Ultra-widefield (UWF) fundus image — 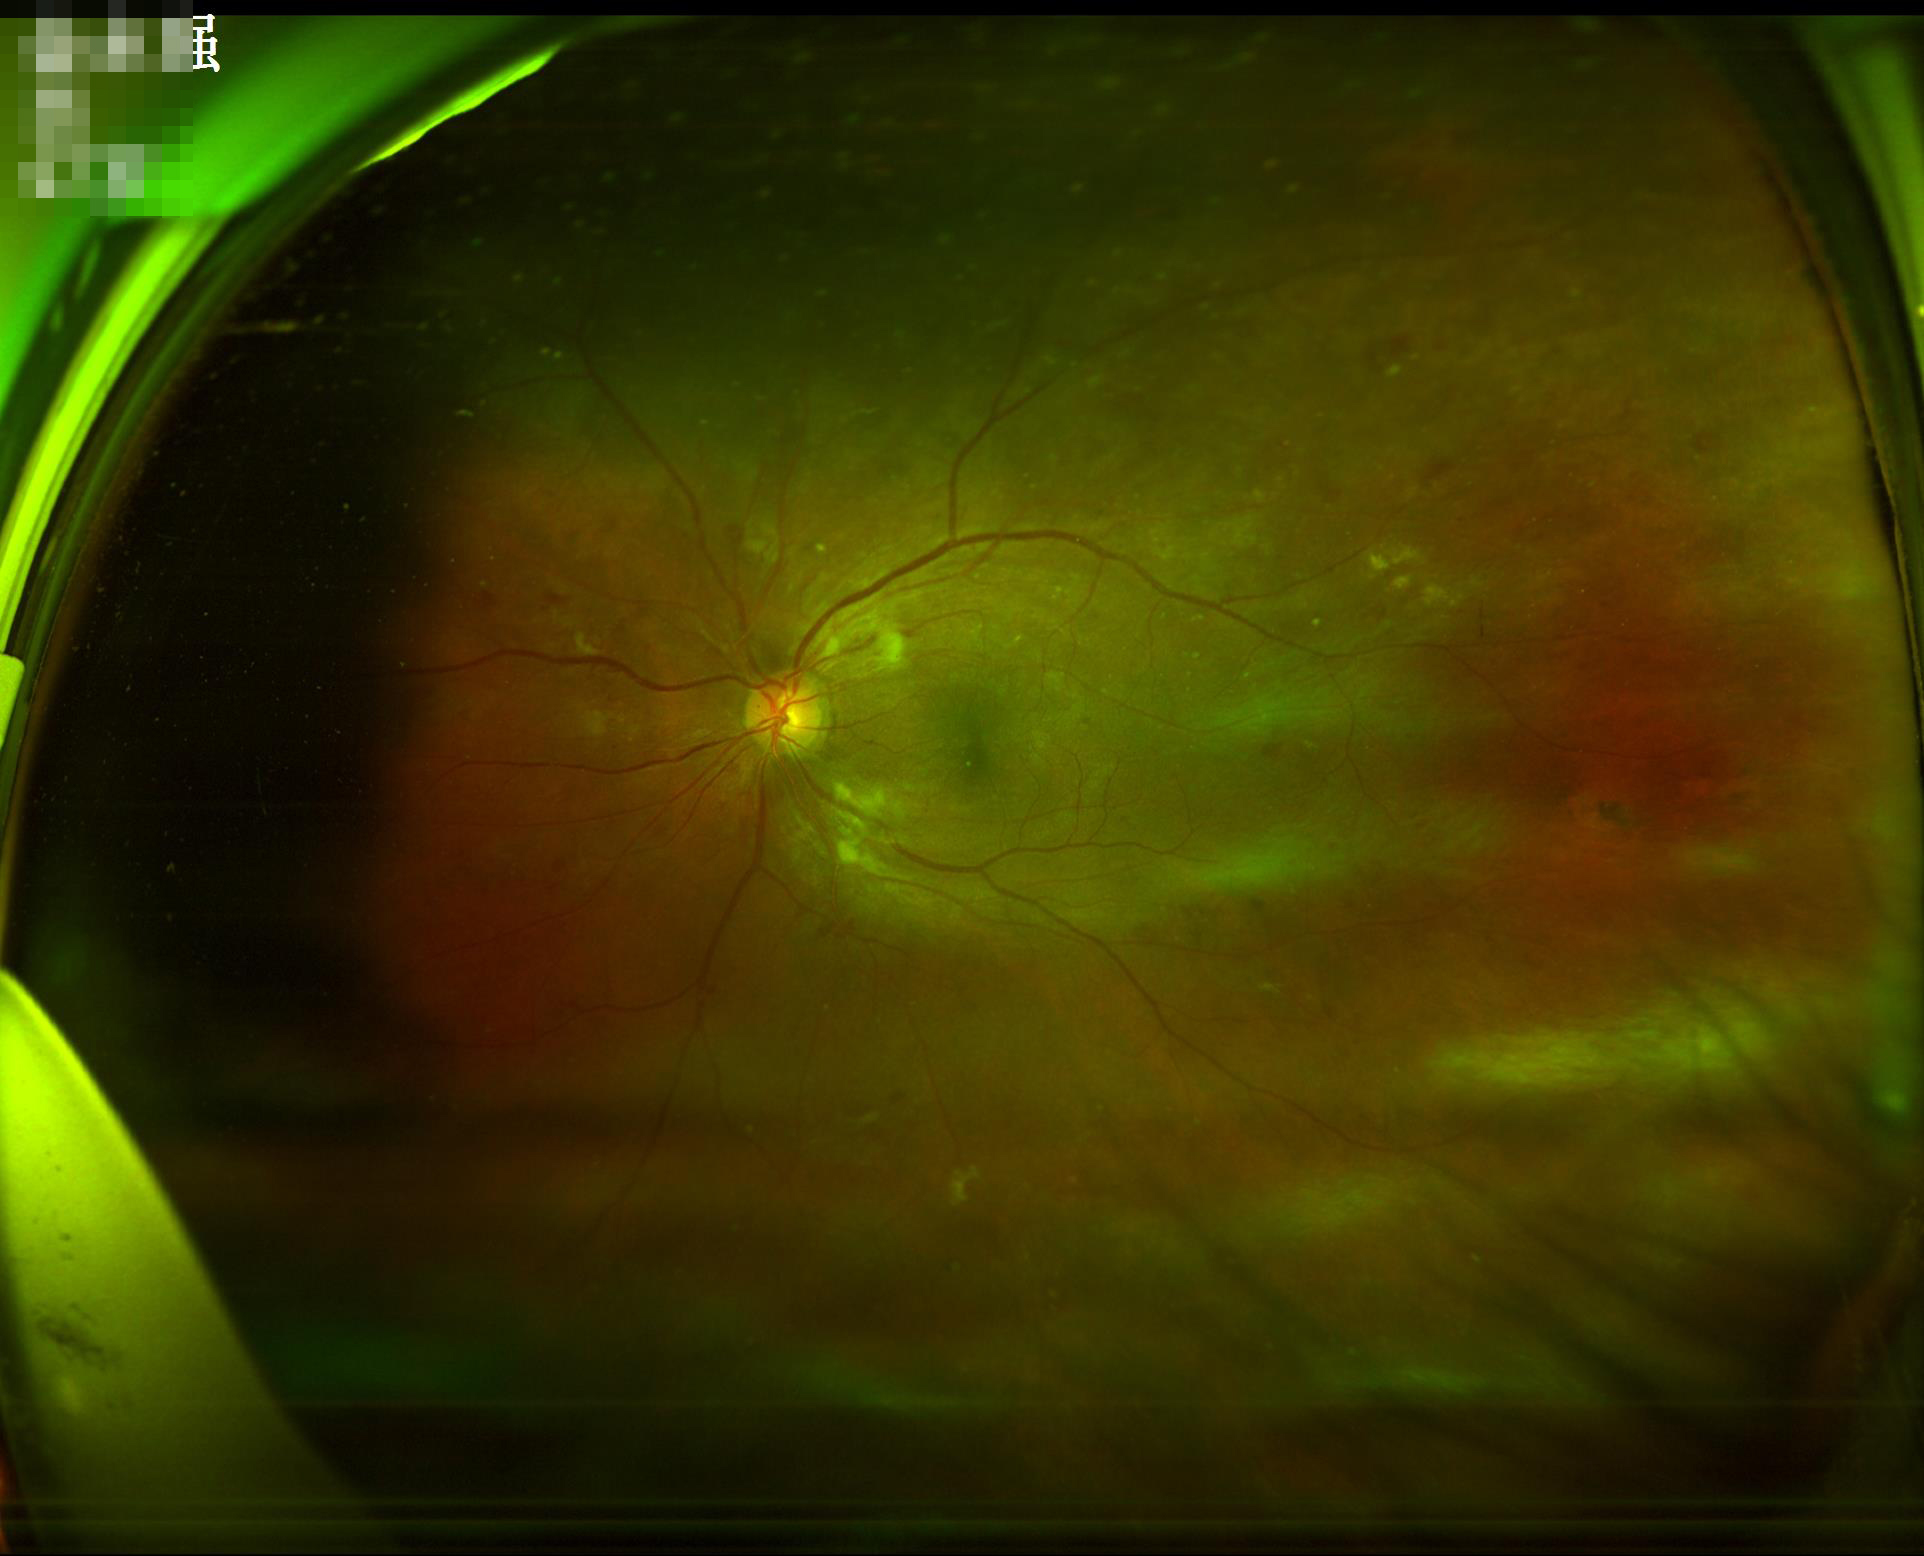
Image quality is suboptimal.
Reduced sharpness with visible blur.
Illumination is uneven.